2048 by 1536 pixels
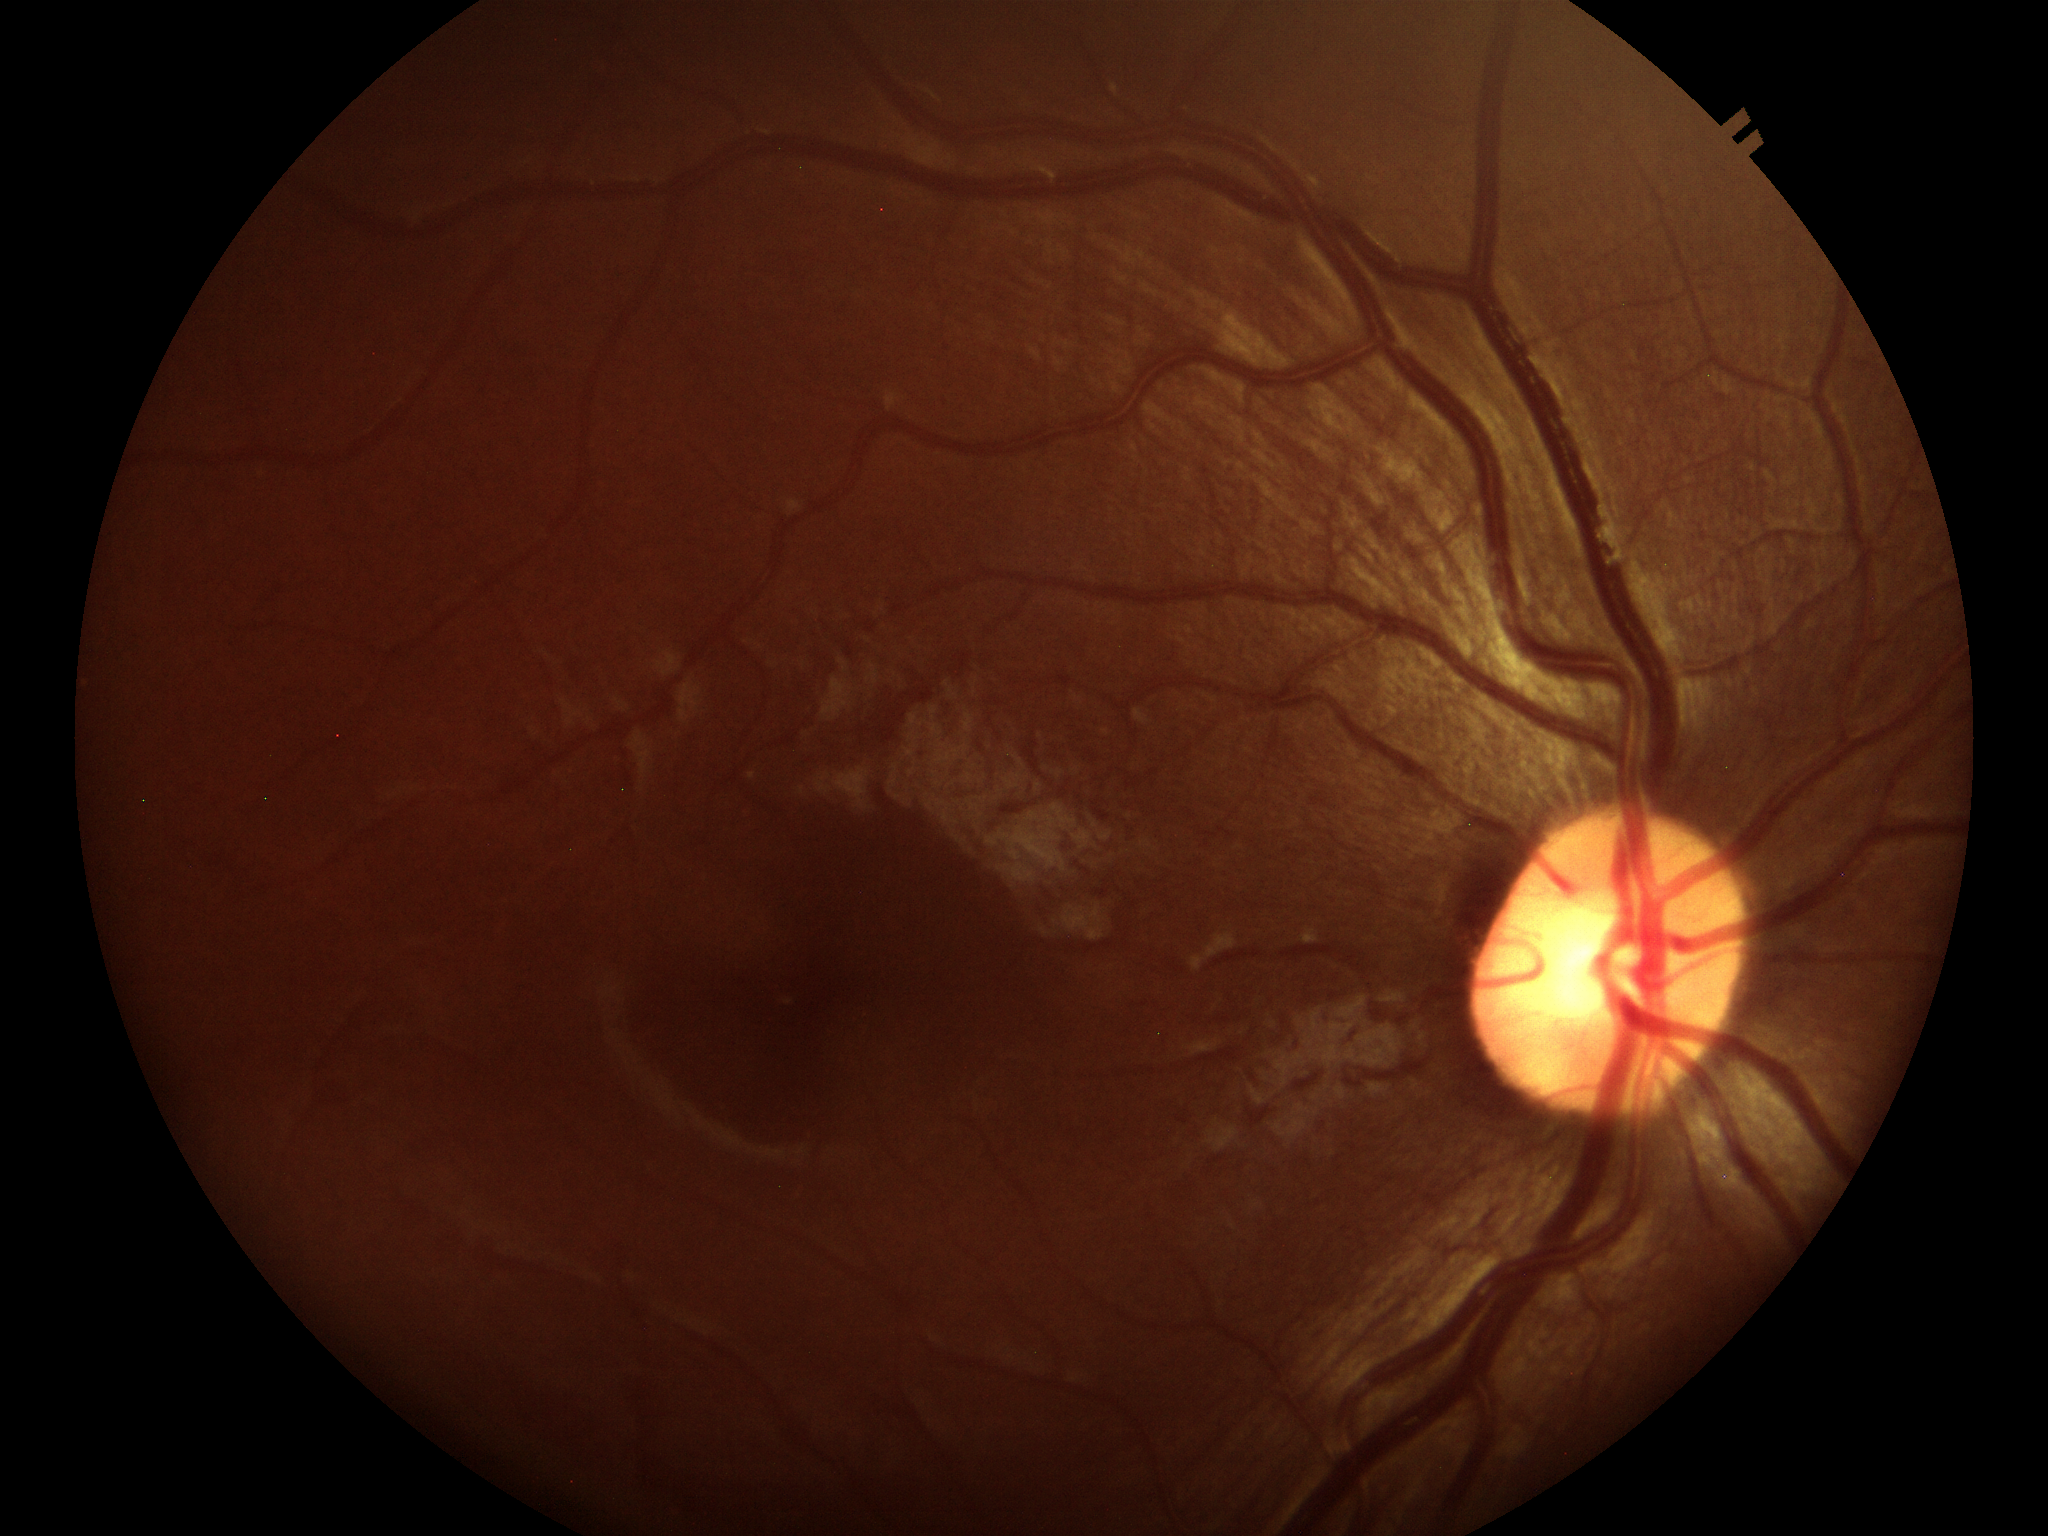
Glaucoma screening impression: negative (unanimous normal call).
VCDR is 0.47.